Image size 1659x2212:
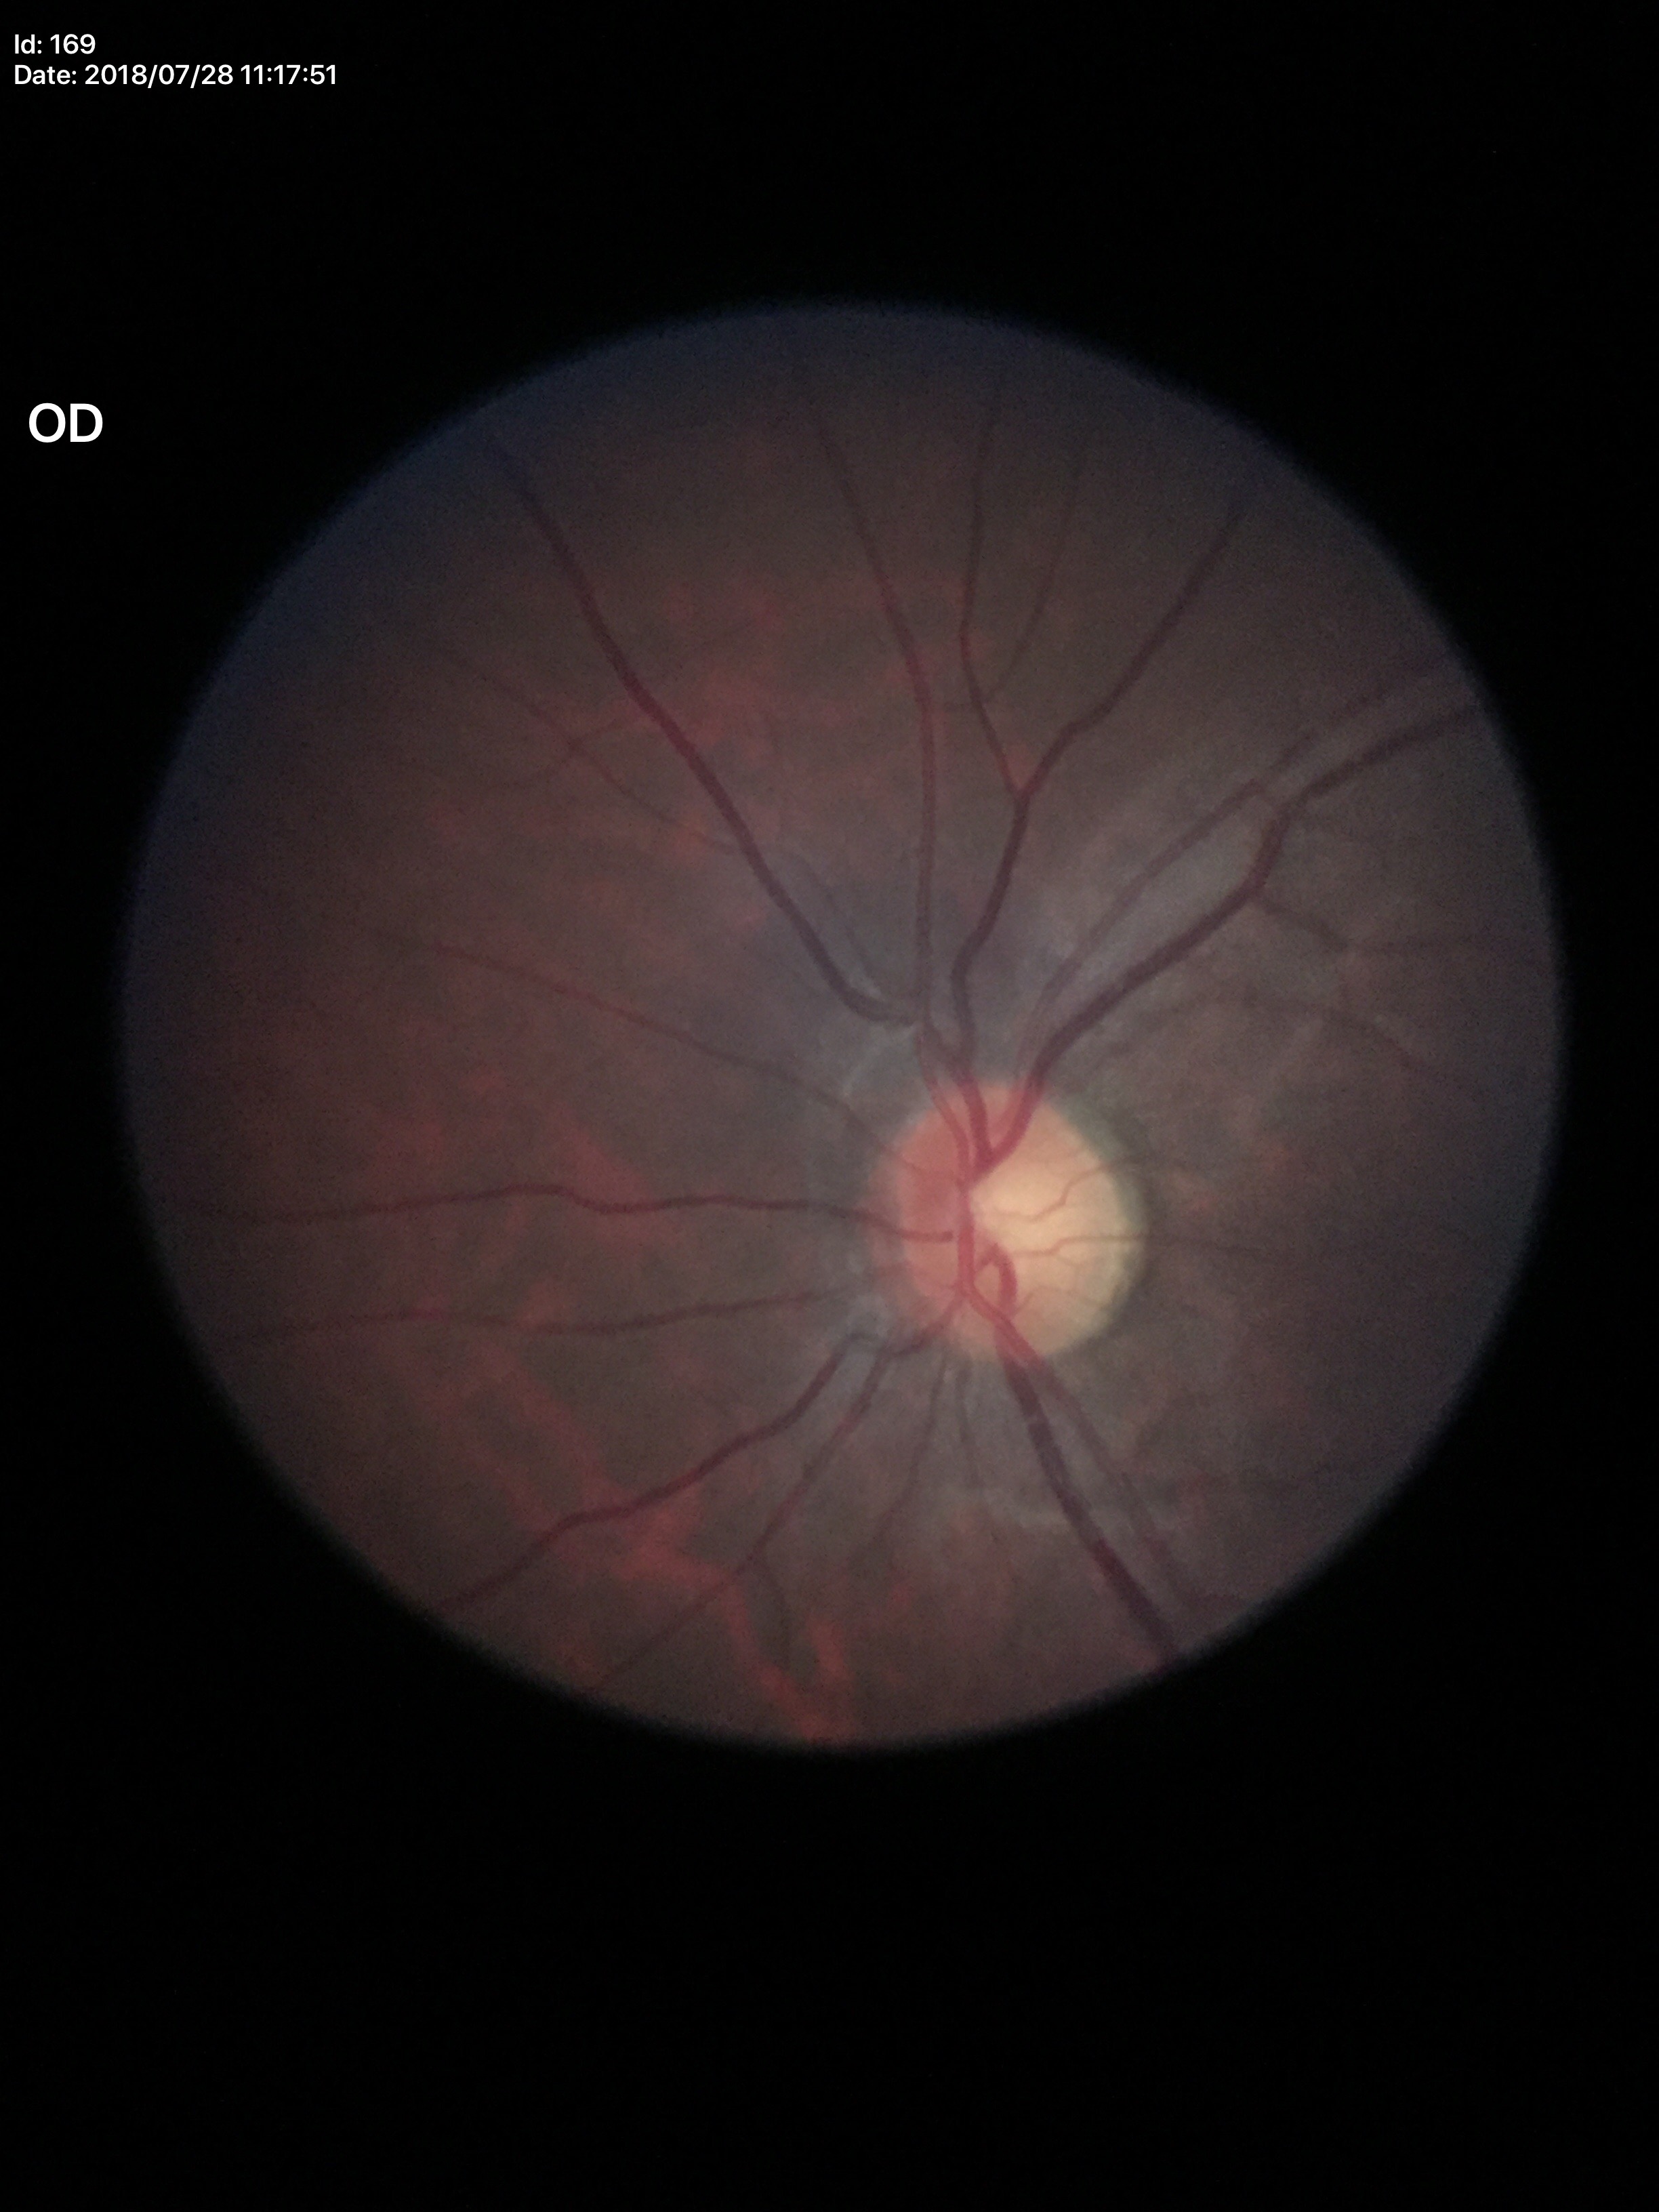

Glaucoma impression: negative.
Vertical CDR (VCDR) is 0.55.
Horizontal cup-to-disc ratio (HCDR) of 0.53.